Camera: NIDEK AFC-230 · modified Davis grading · nonmydriatic fundus photograph · color fundus photograph · FOV: 45 degrees · 848 by 848 pixels — 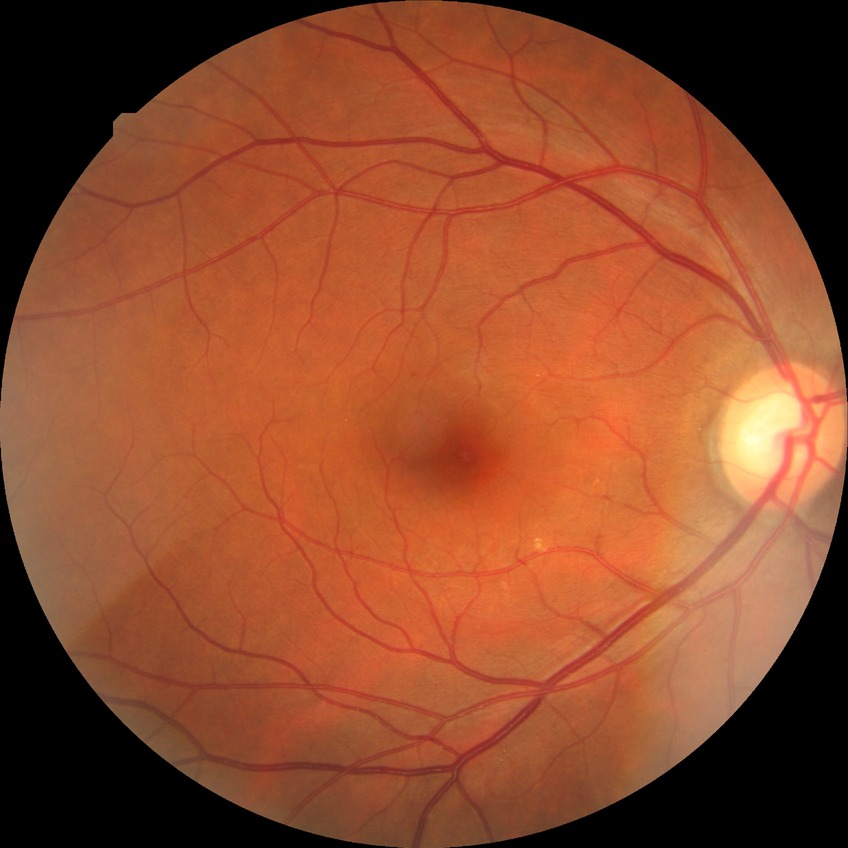 davis_grade: no diabetic retinopathy (NDR)